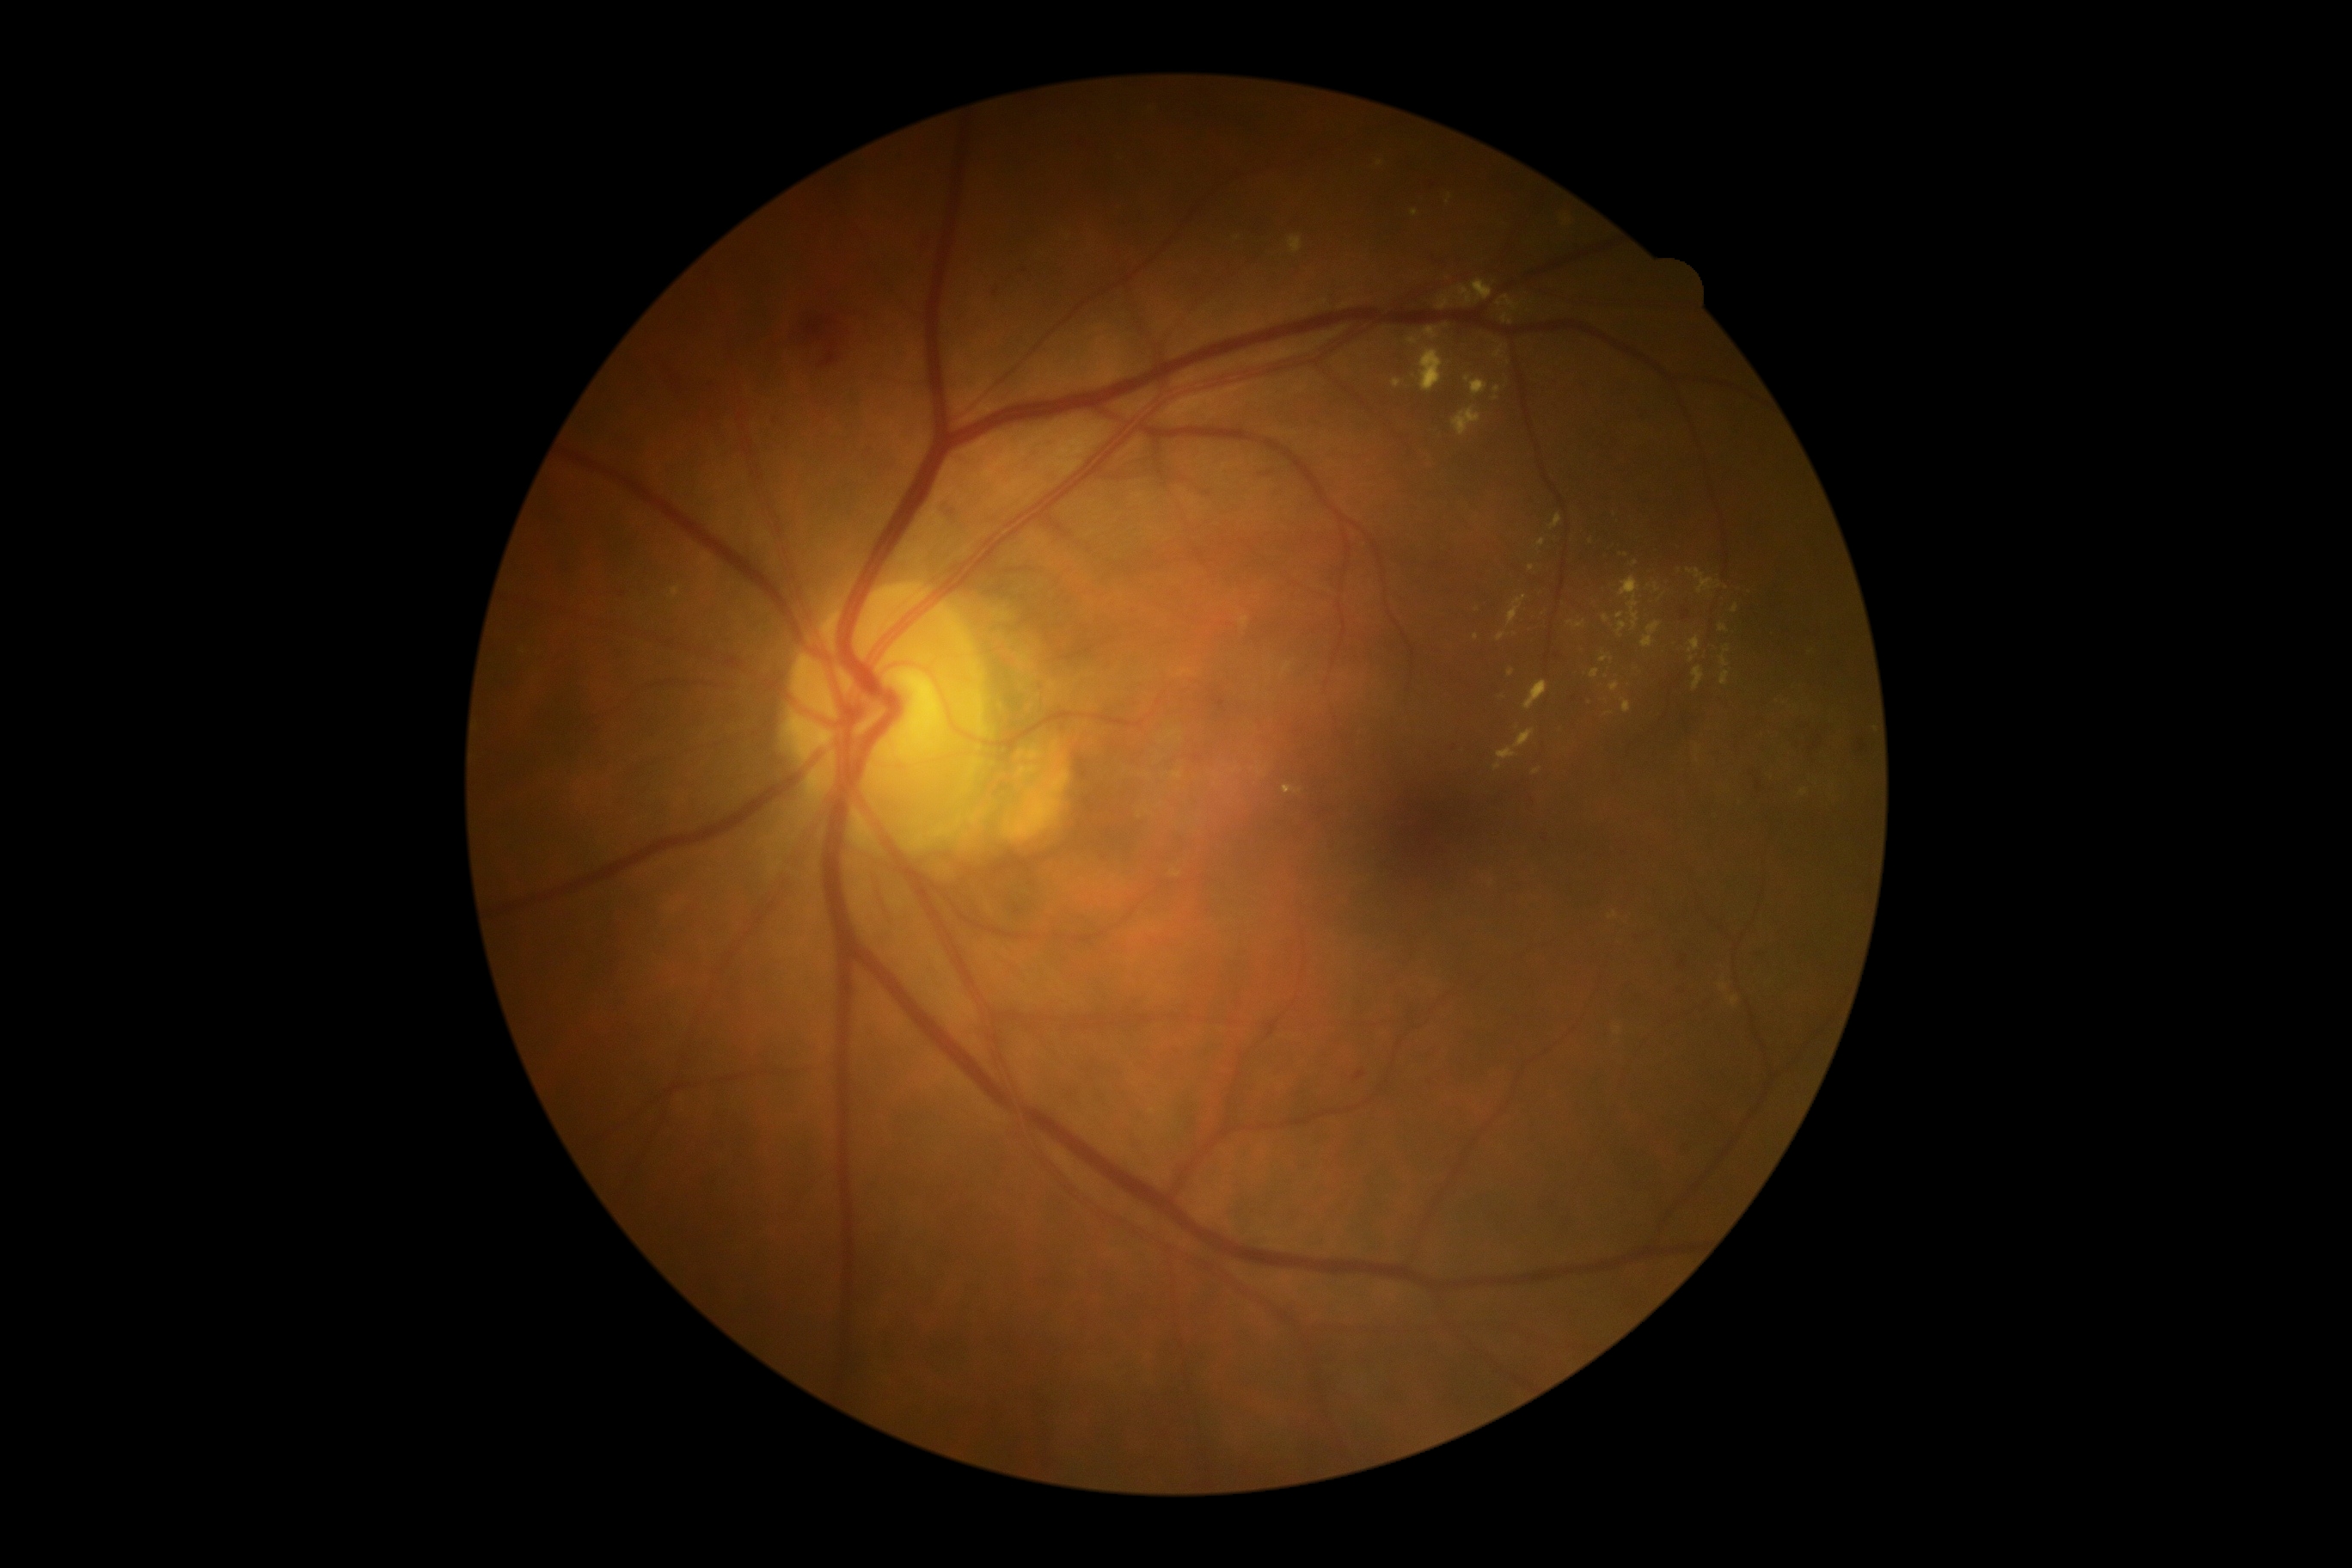
DR severity is moderate non-proliferative diabetic retinopathy (grade 2).